Wide-field fundus image from infant ROP screening: 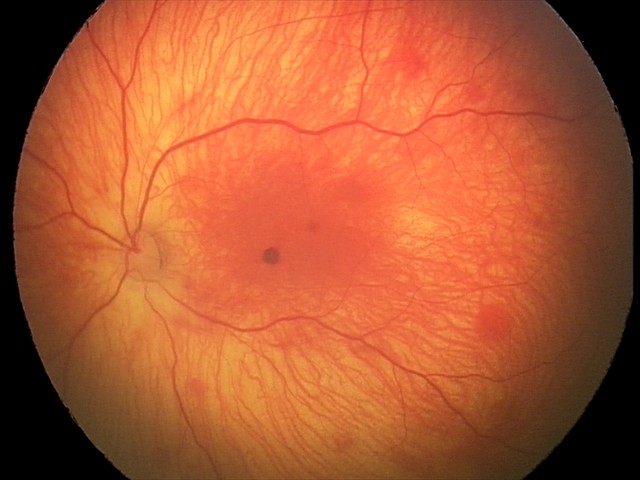
Examination diagnosed as retinal hemorrhages.